45° FOV:
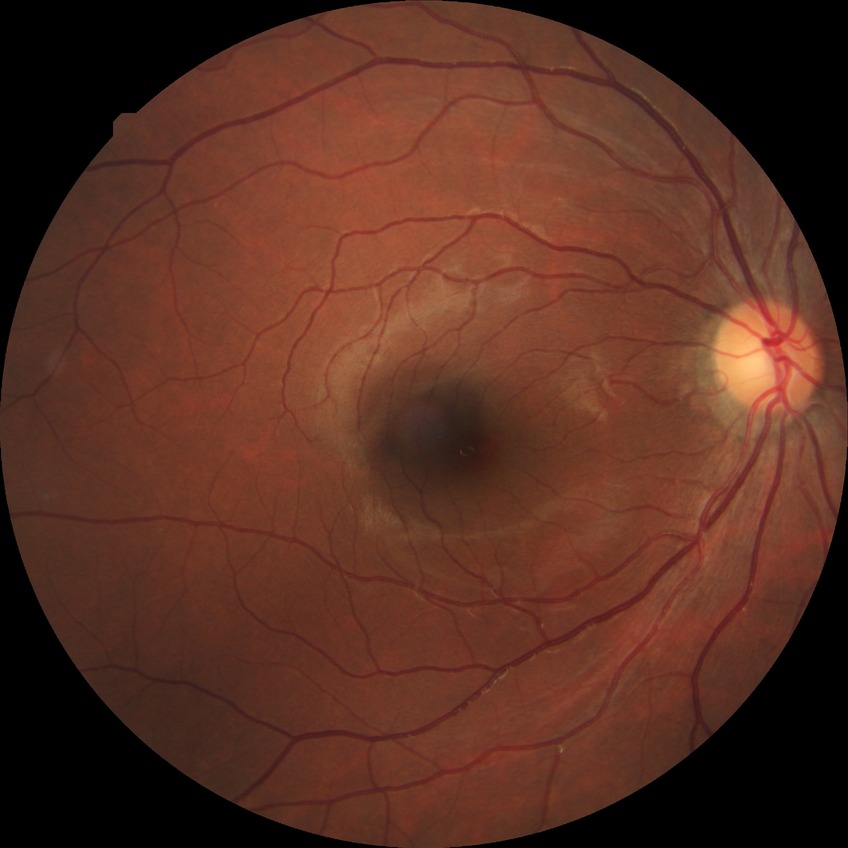

DR: NDR.
No apparent diabetic retinopathy.